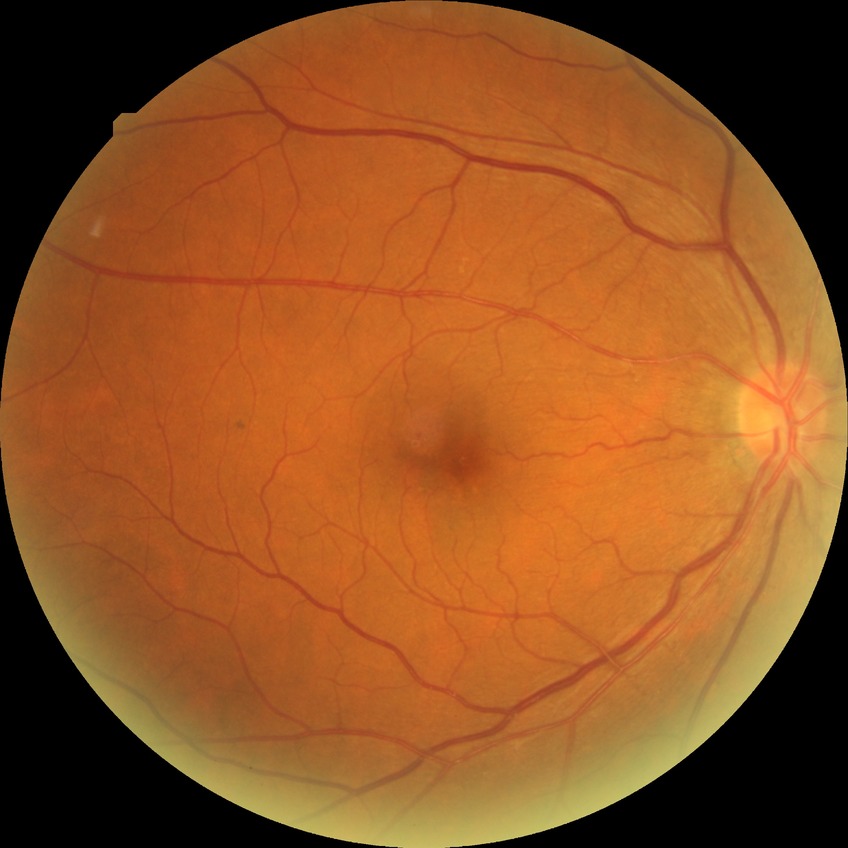 * DR grade — NDR